1920x1440px — 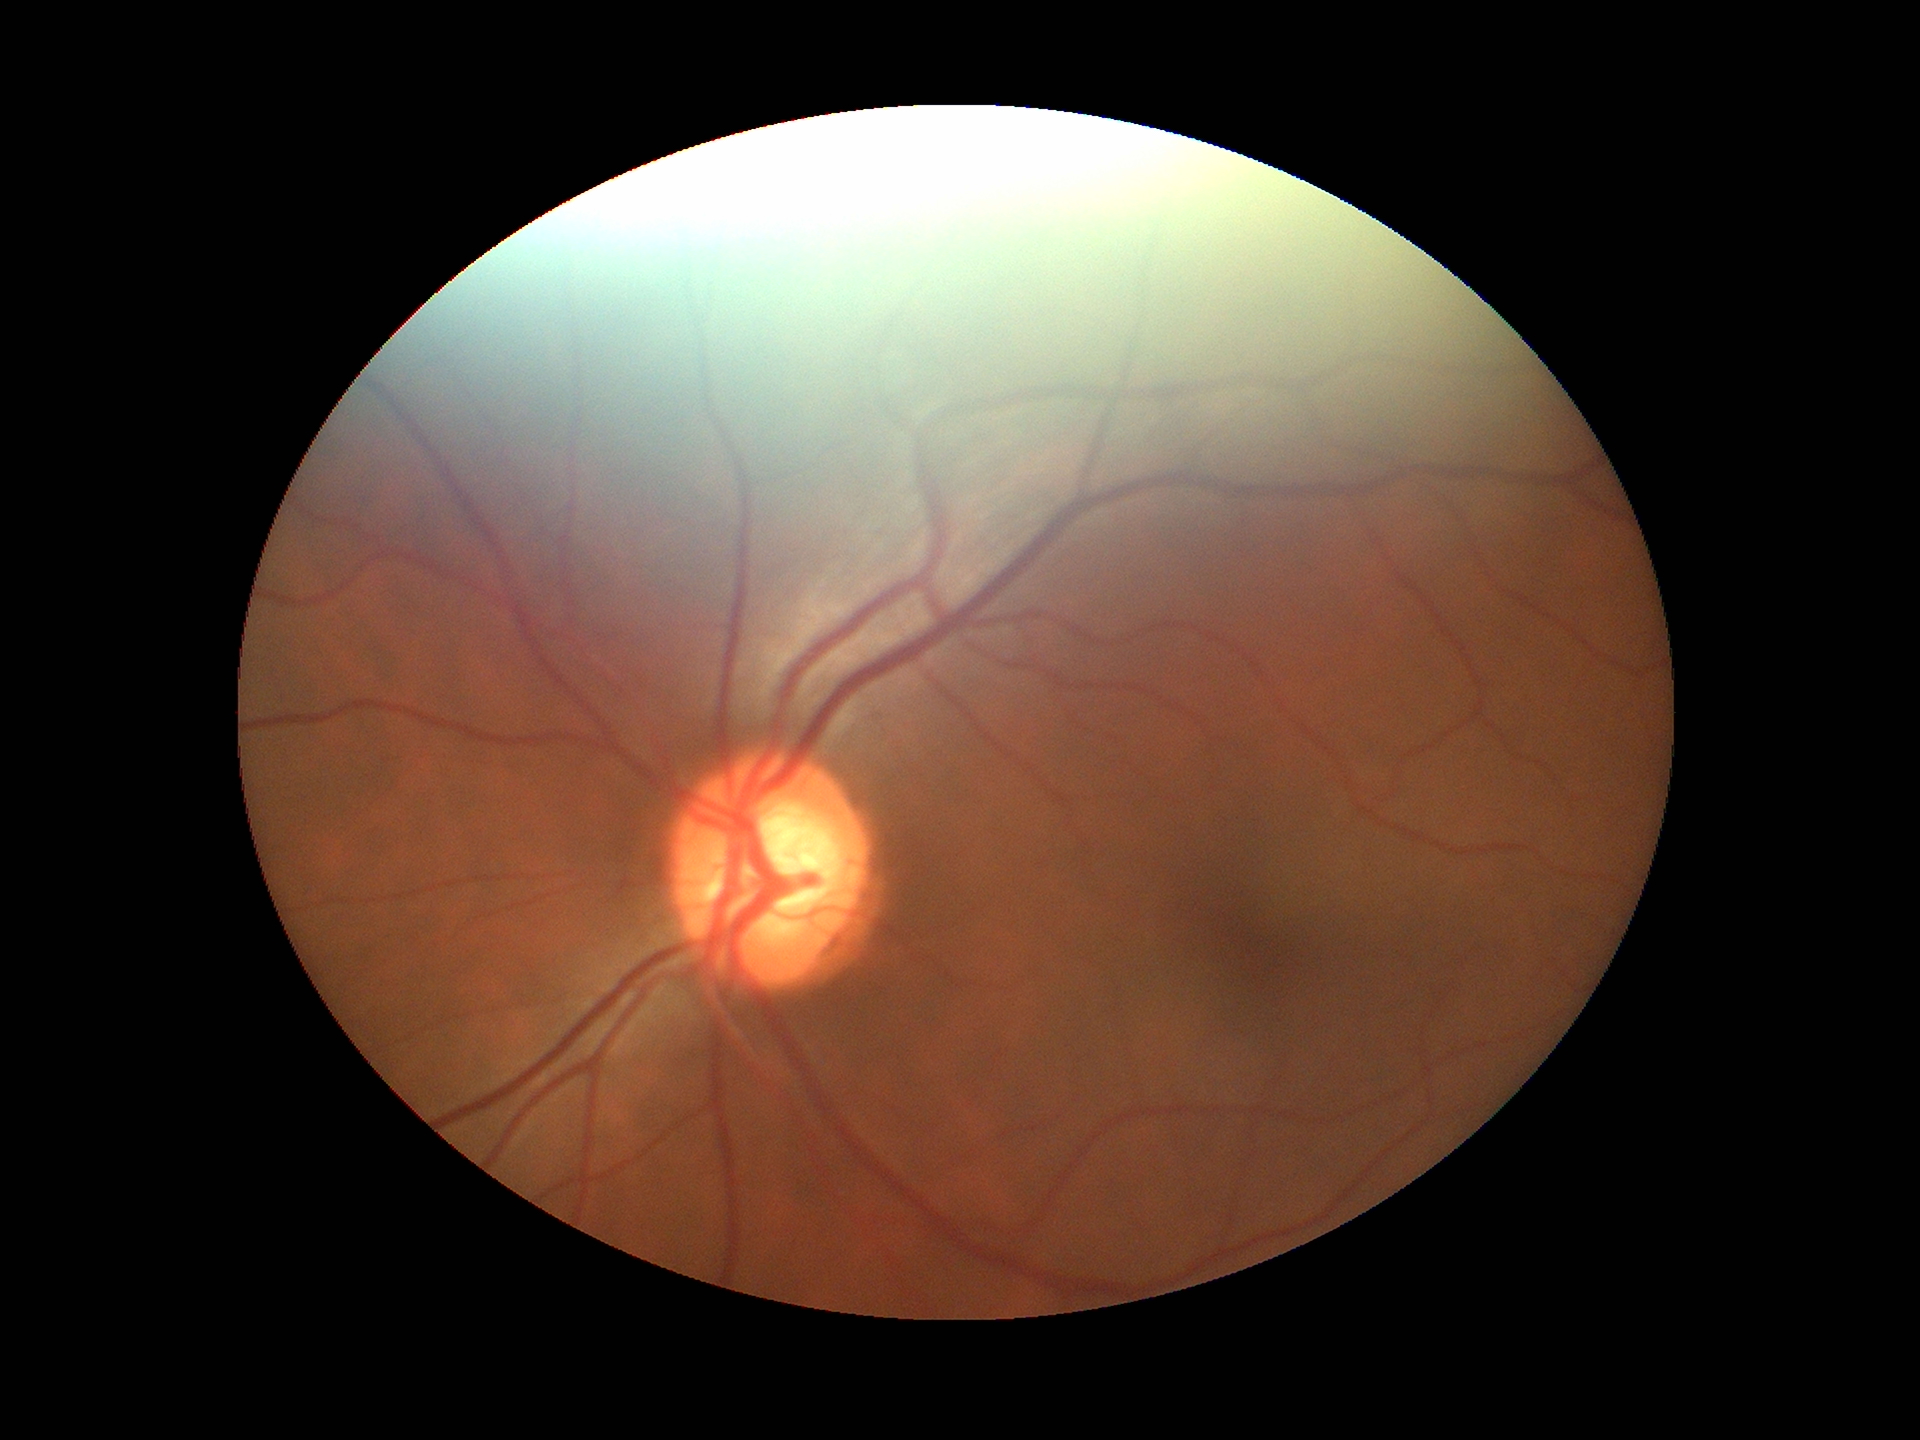
Vertical cup-disc ratio (VCDR) is 0.58. Glaucoma assessment: negative (one of five ophthalmologists flagged glaucoma suspect).